Image size 2212x1659 · 45° field of view: 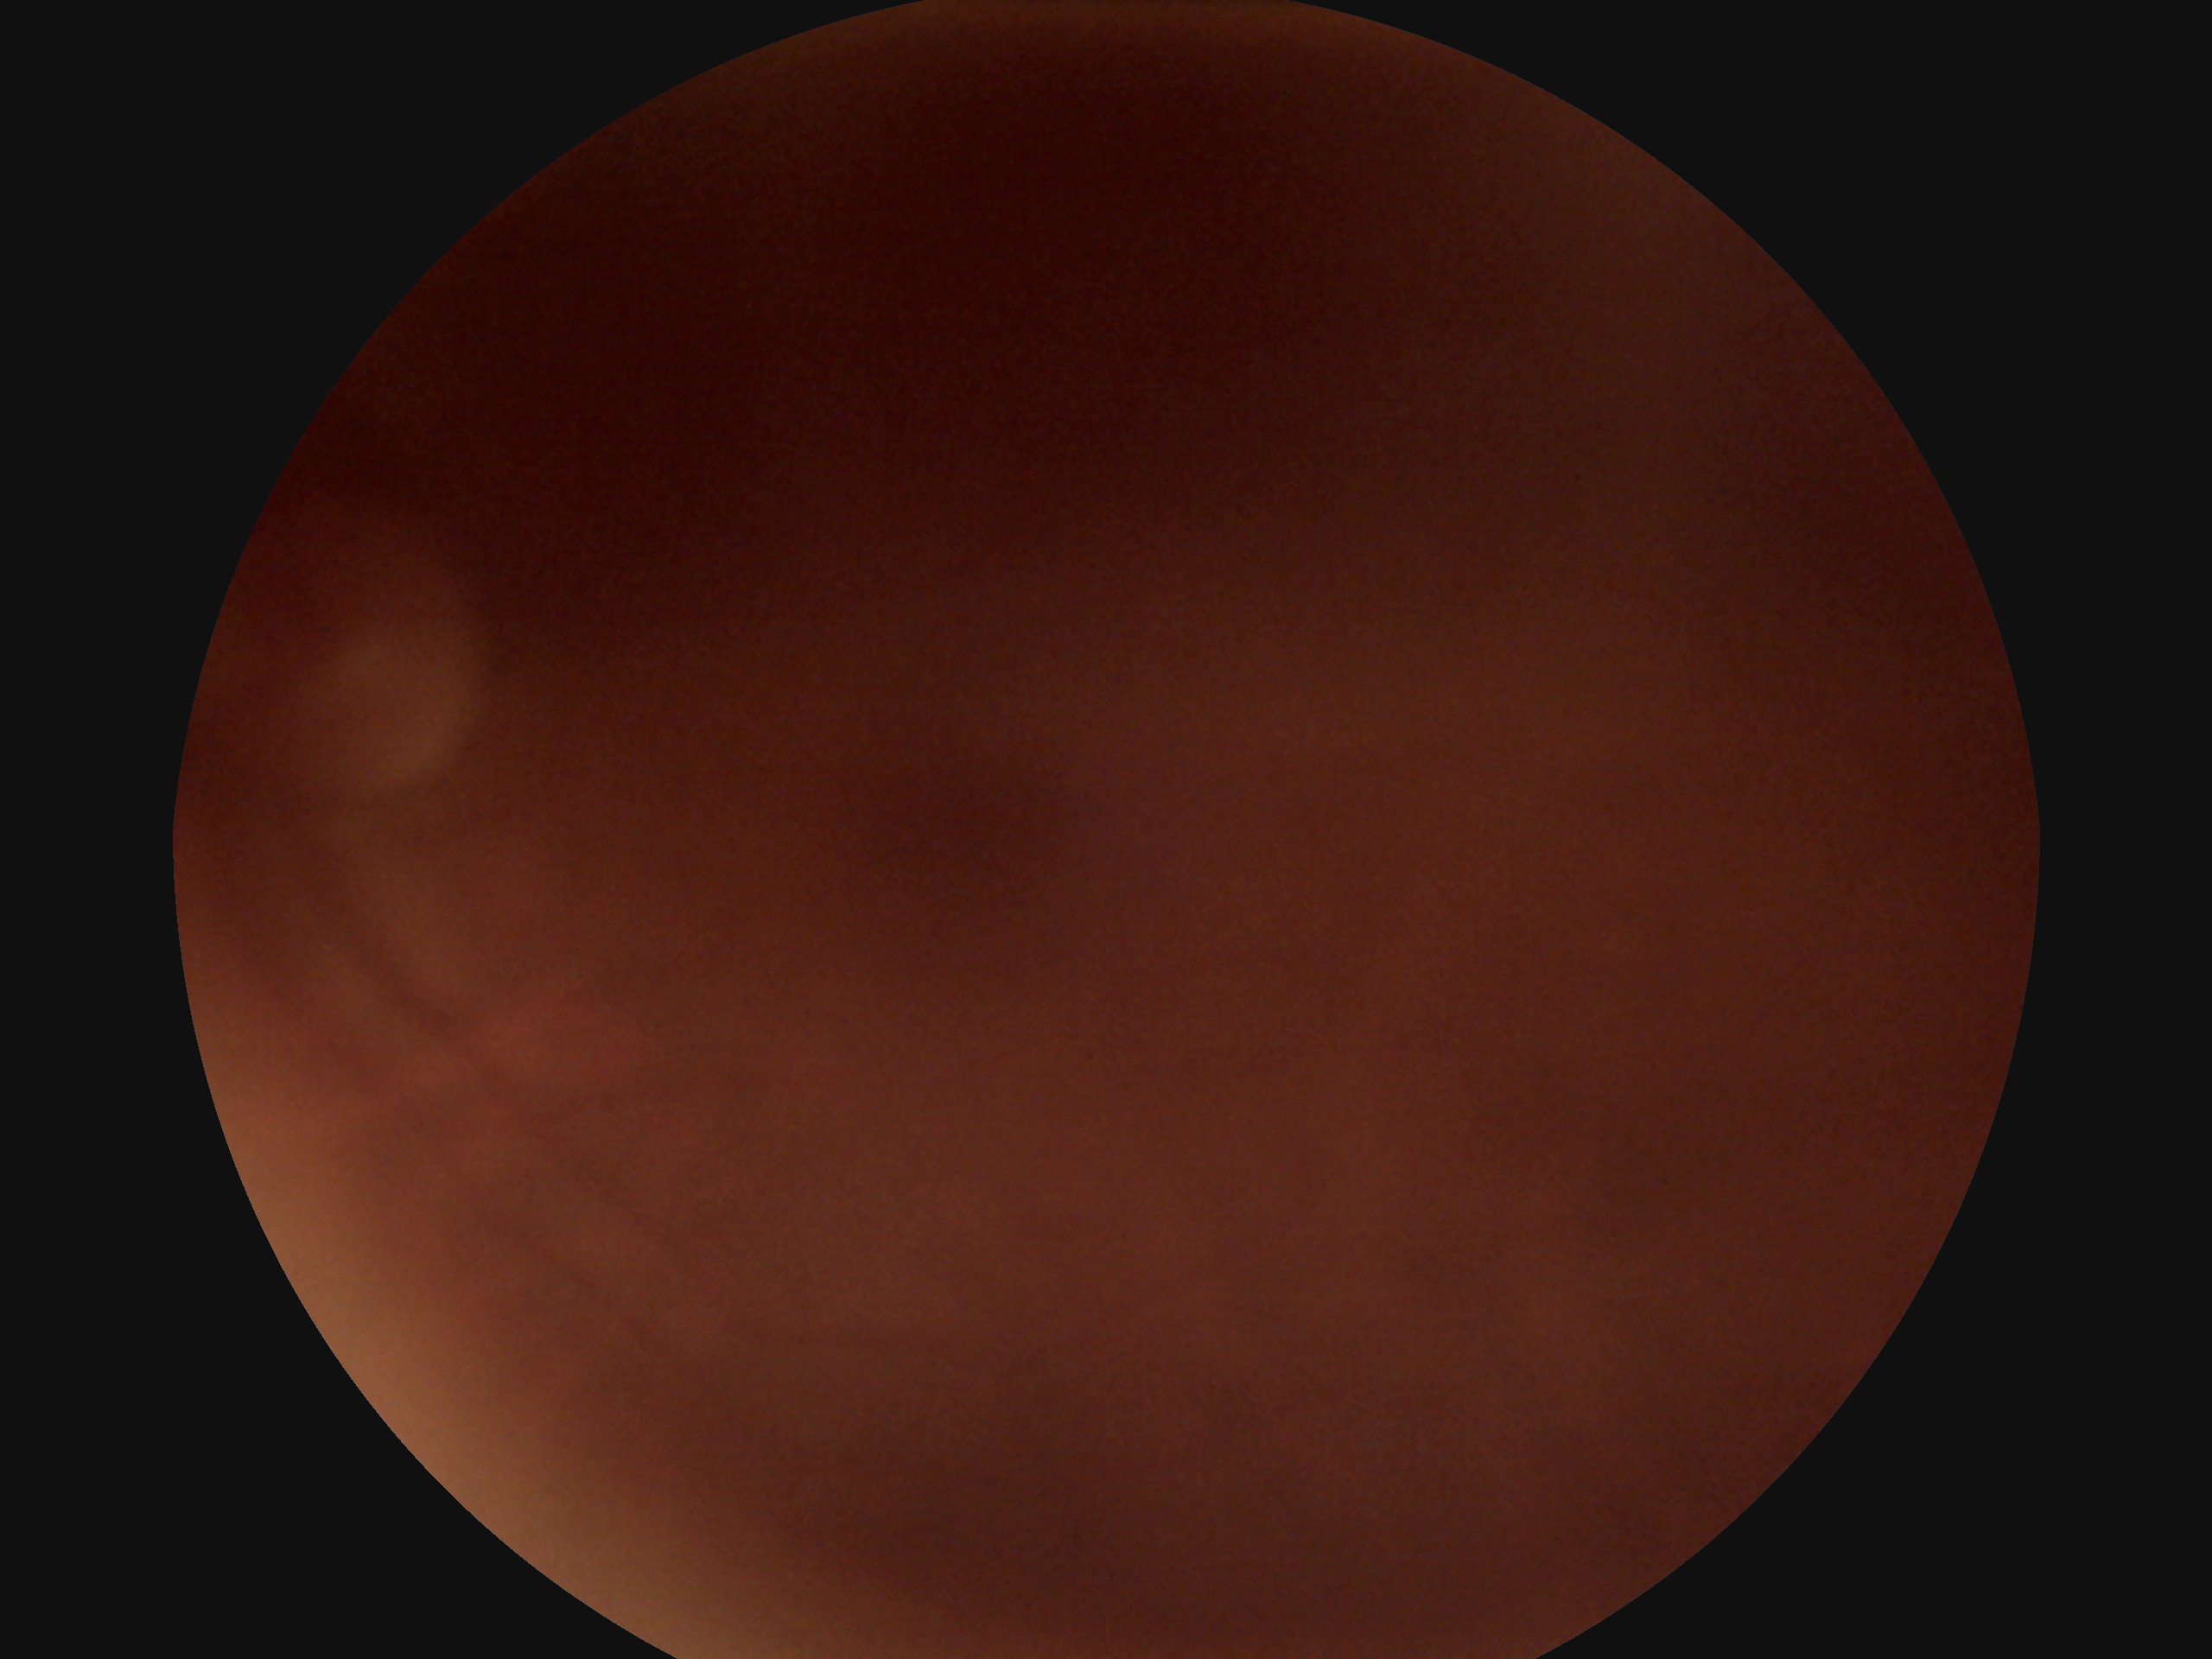 Quality too poor to assess for DR. Diabetic retinopathy (DR) is ungradable due to poor image quality.